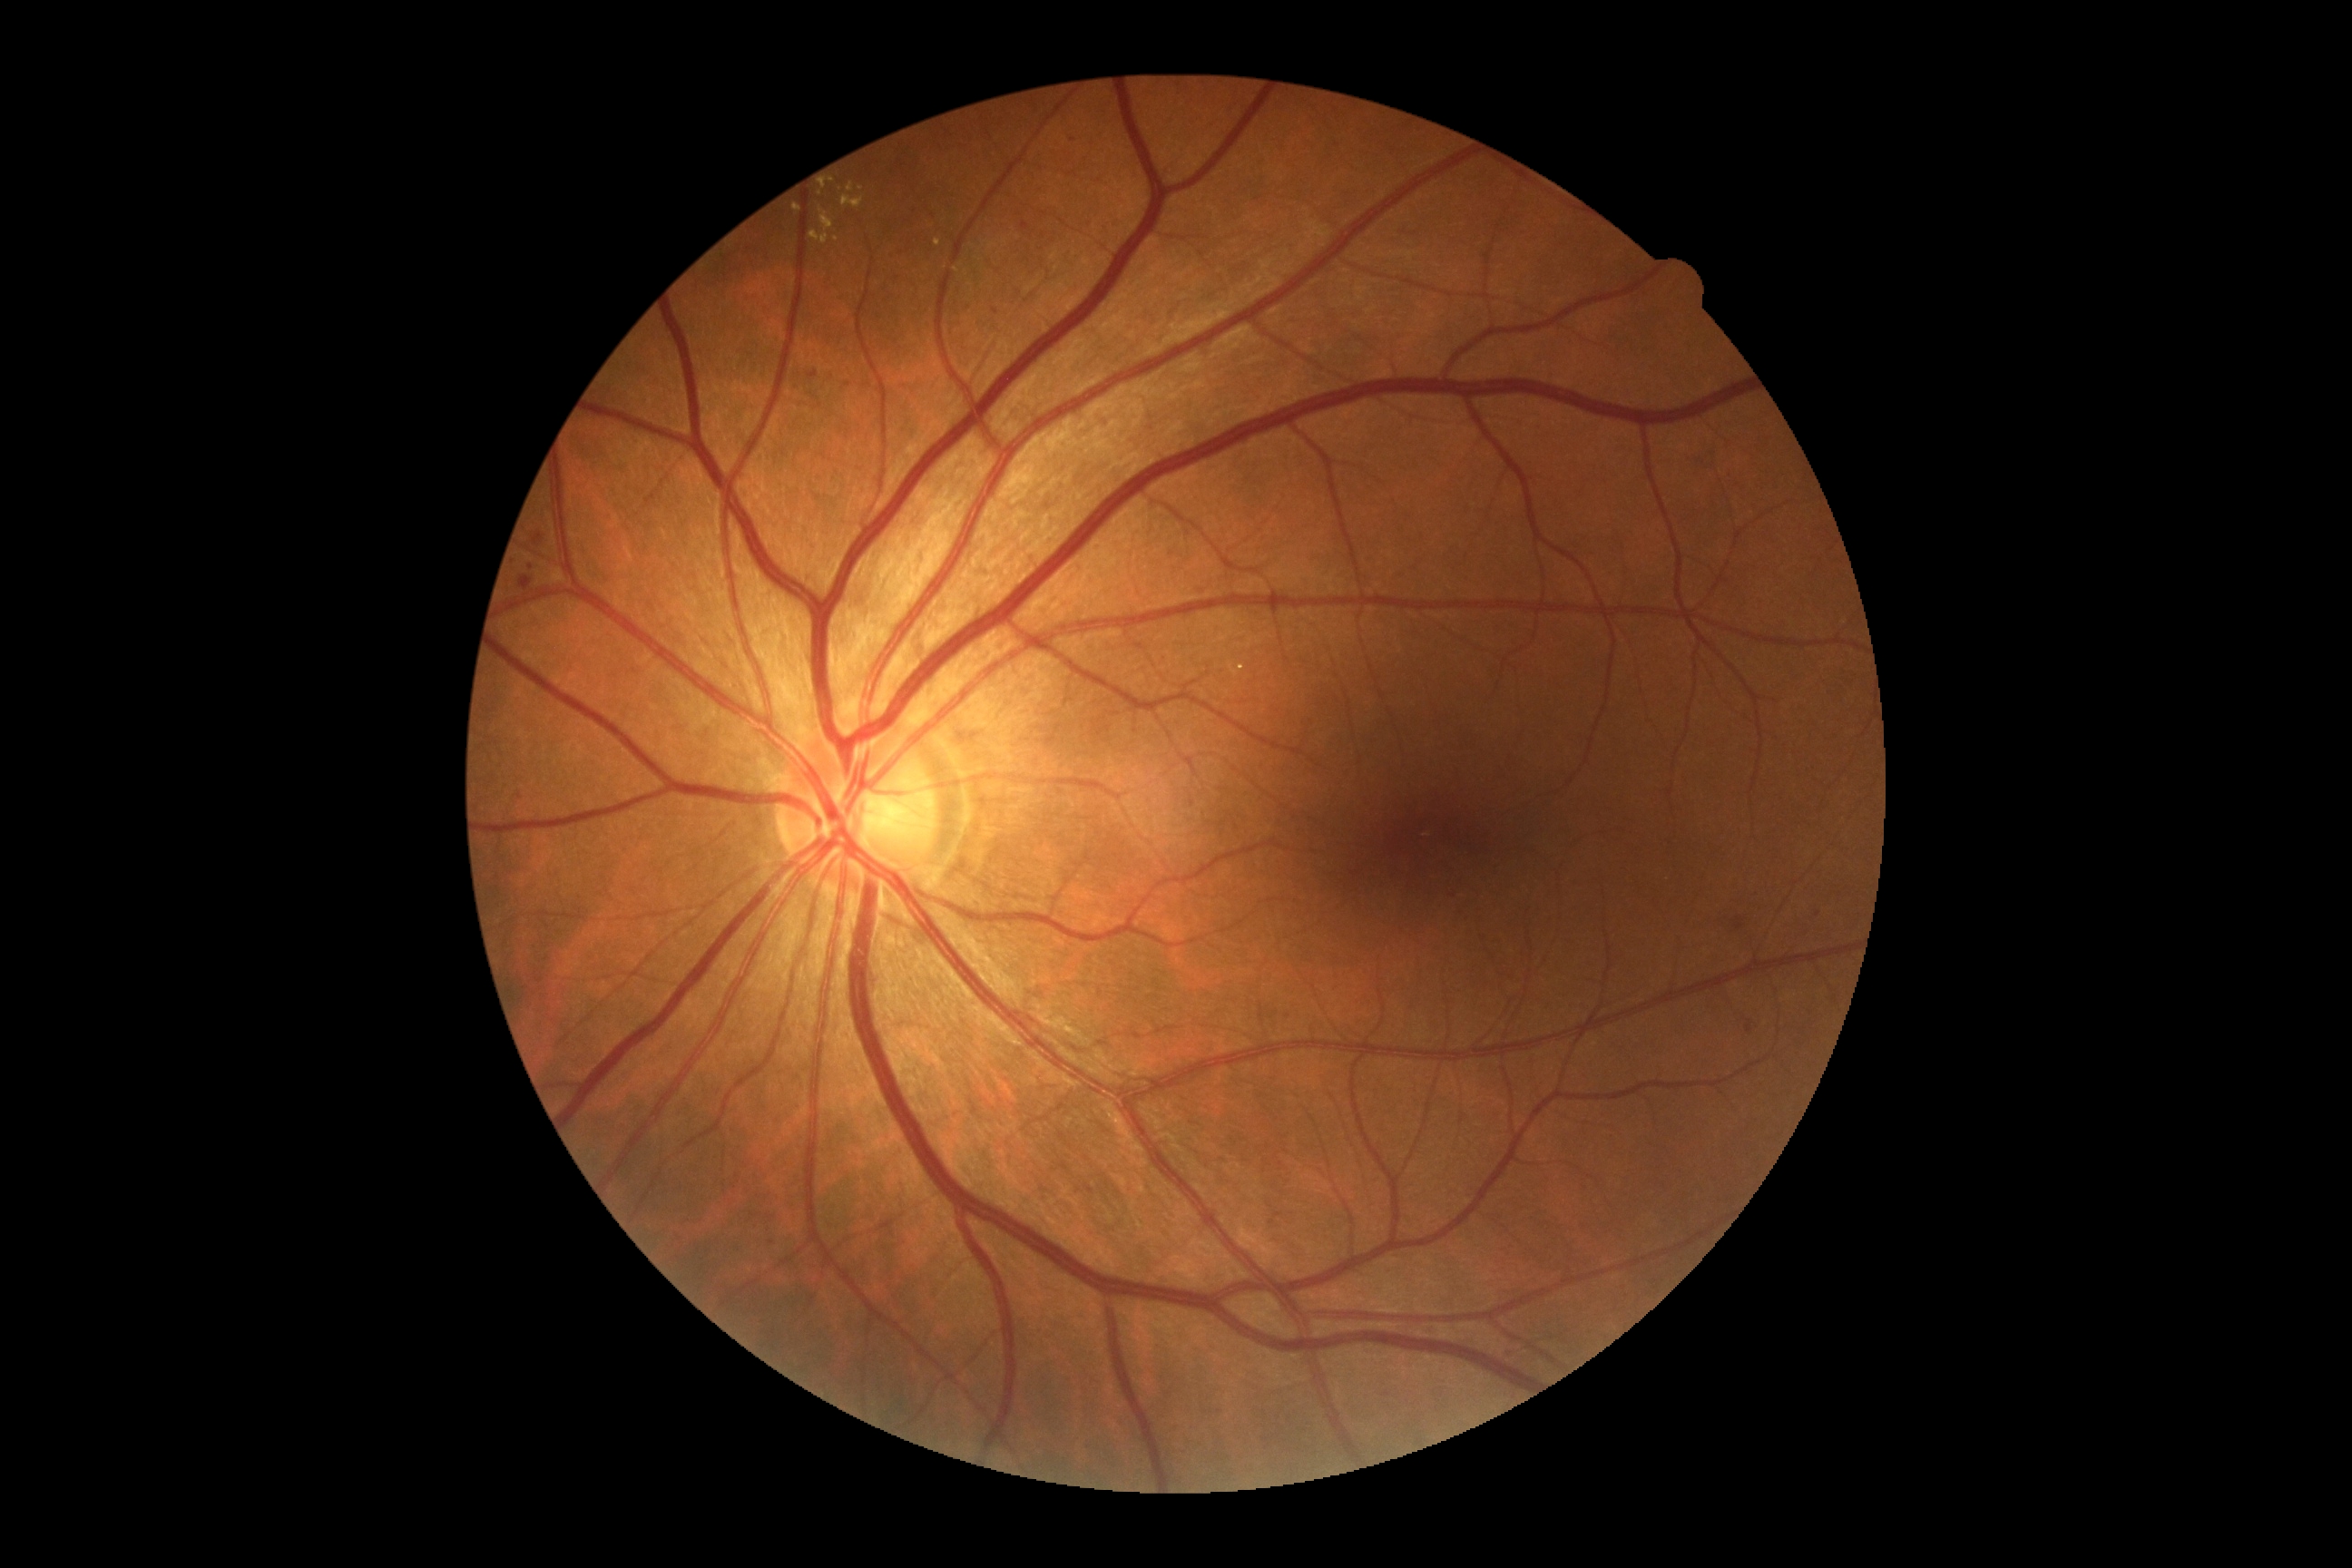

diabetic retinopathy (DR) = moderate NPDR (grade 2).